Davis DR grading.
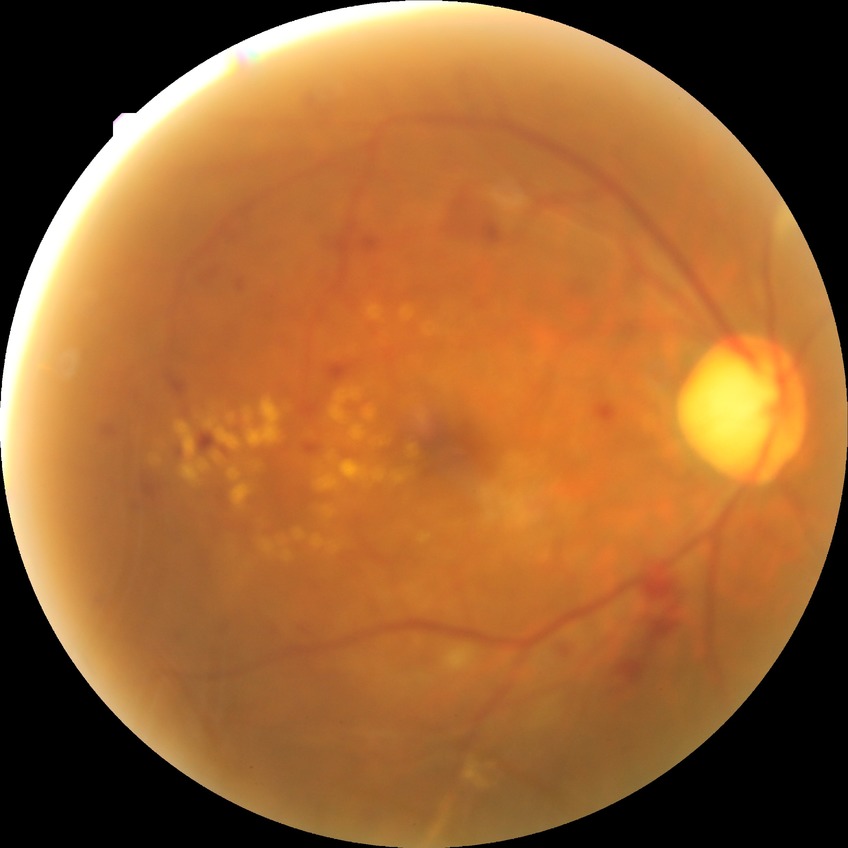 DR stage: PDR.